Color fundus image; 848 x 848 pixels — 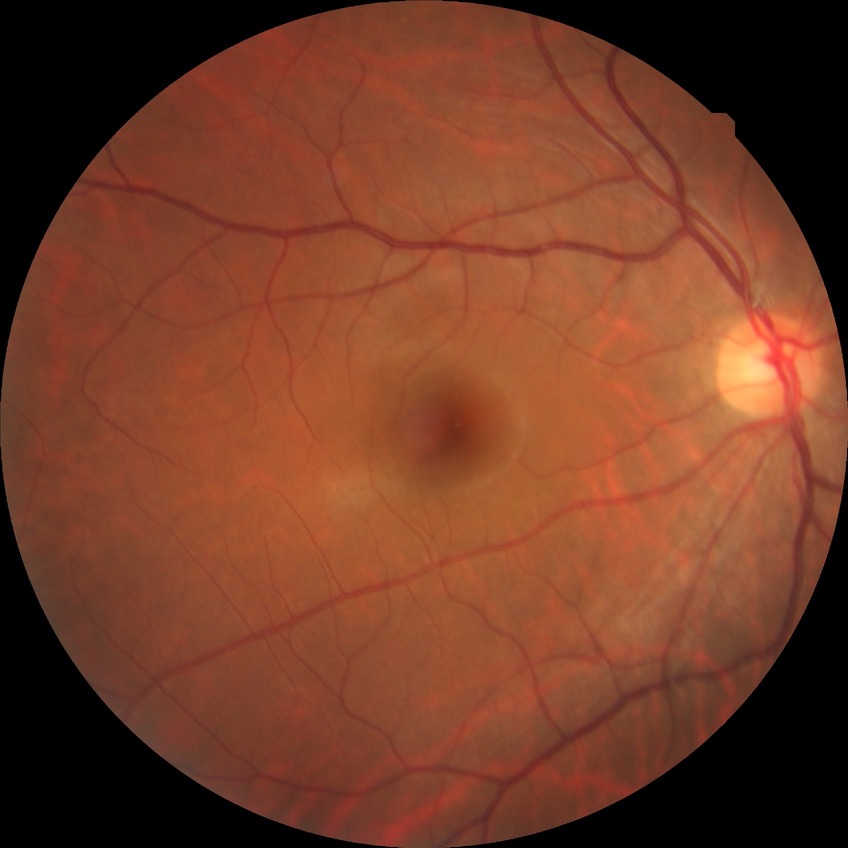 Diabetic retinopathy (DR) is NDR (no diabetic retinopathy).